Color fundus photograph
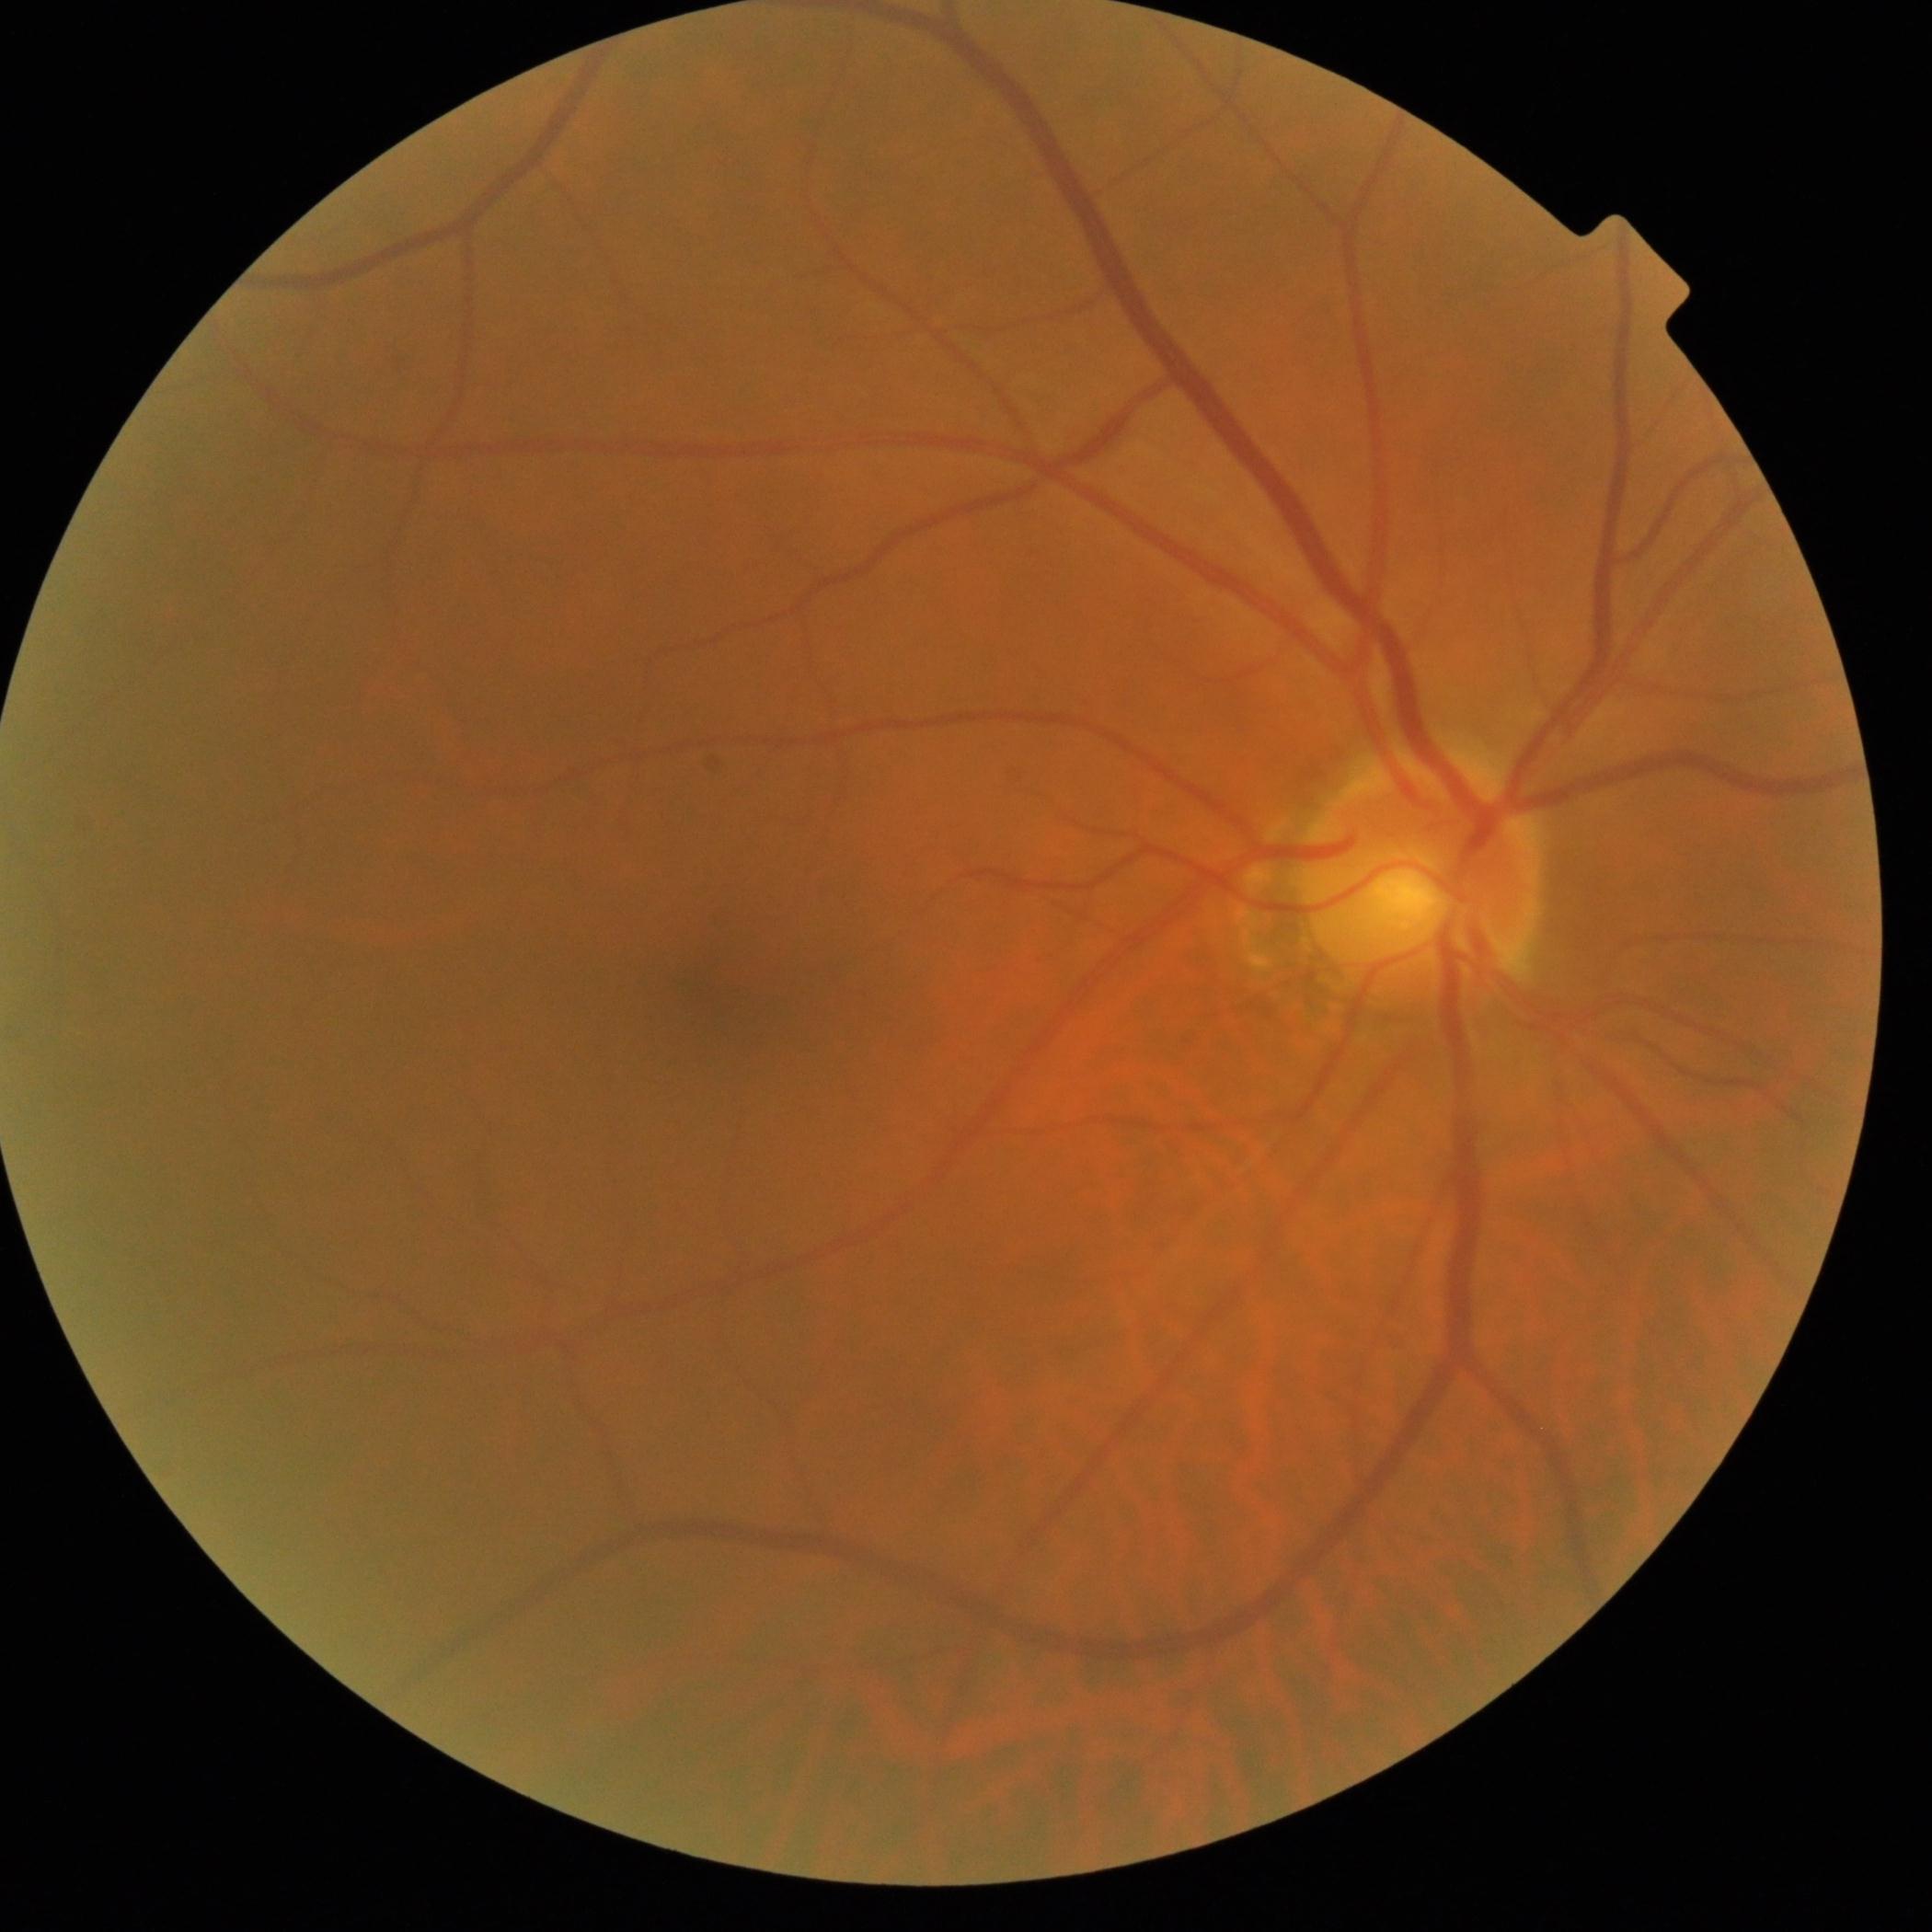
DR grade: no apparent diabetic retinopathy (0).